343 x 343 pixels, optic nerve head photograph, mydriatic acquisition — 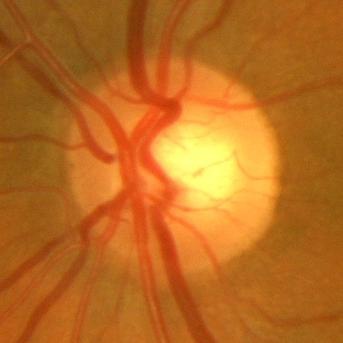 There is evidence of no glaucomatous changes.